Wide-field fundus photograph from neonatal ROP screening; captured with the Clarity RetCam 3 (130° field of view); 640 x 480 pixels
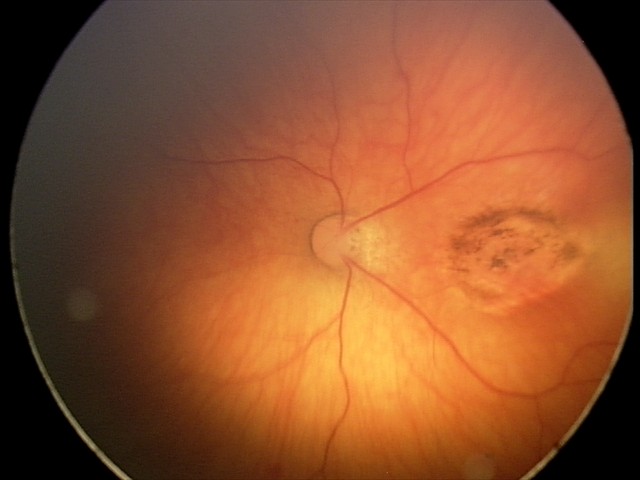
Screening examination consistent with toxoplasmosis chorioretinitis.